Graded on the modified Davis scale — 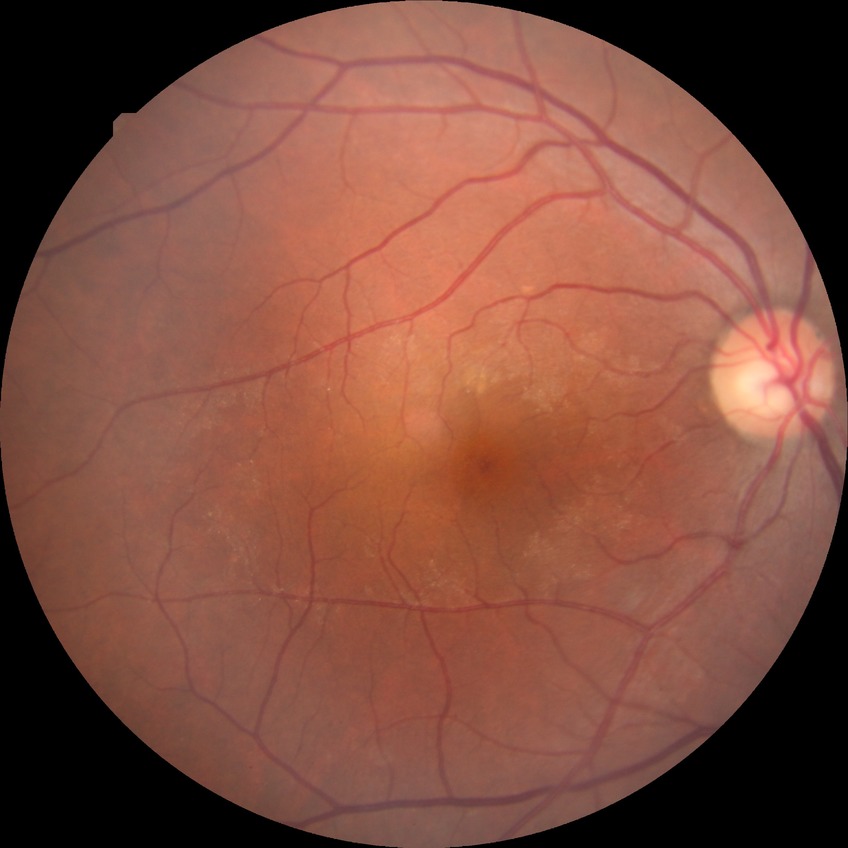

diabetic retinopathy (DR)@NDR (no diabetic retinopathy).